Captured with the Phoenix ICON (100° field of view) · infant wide-field fundus photograph · 1240x1240px.
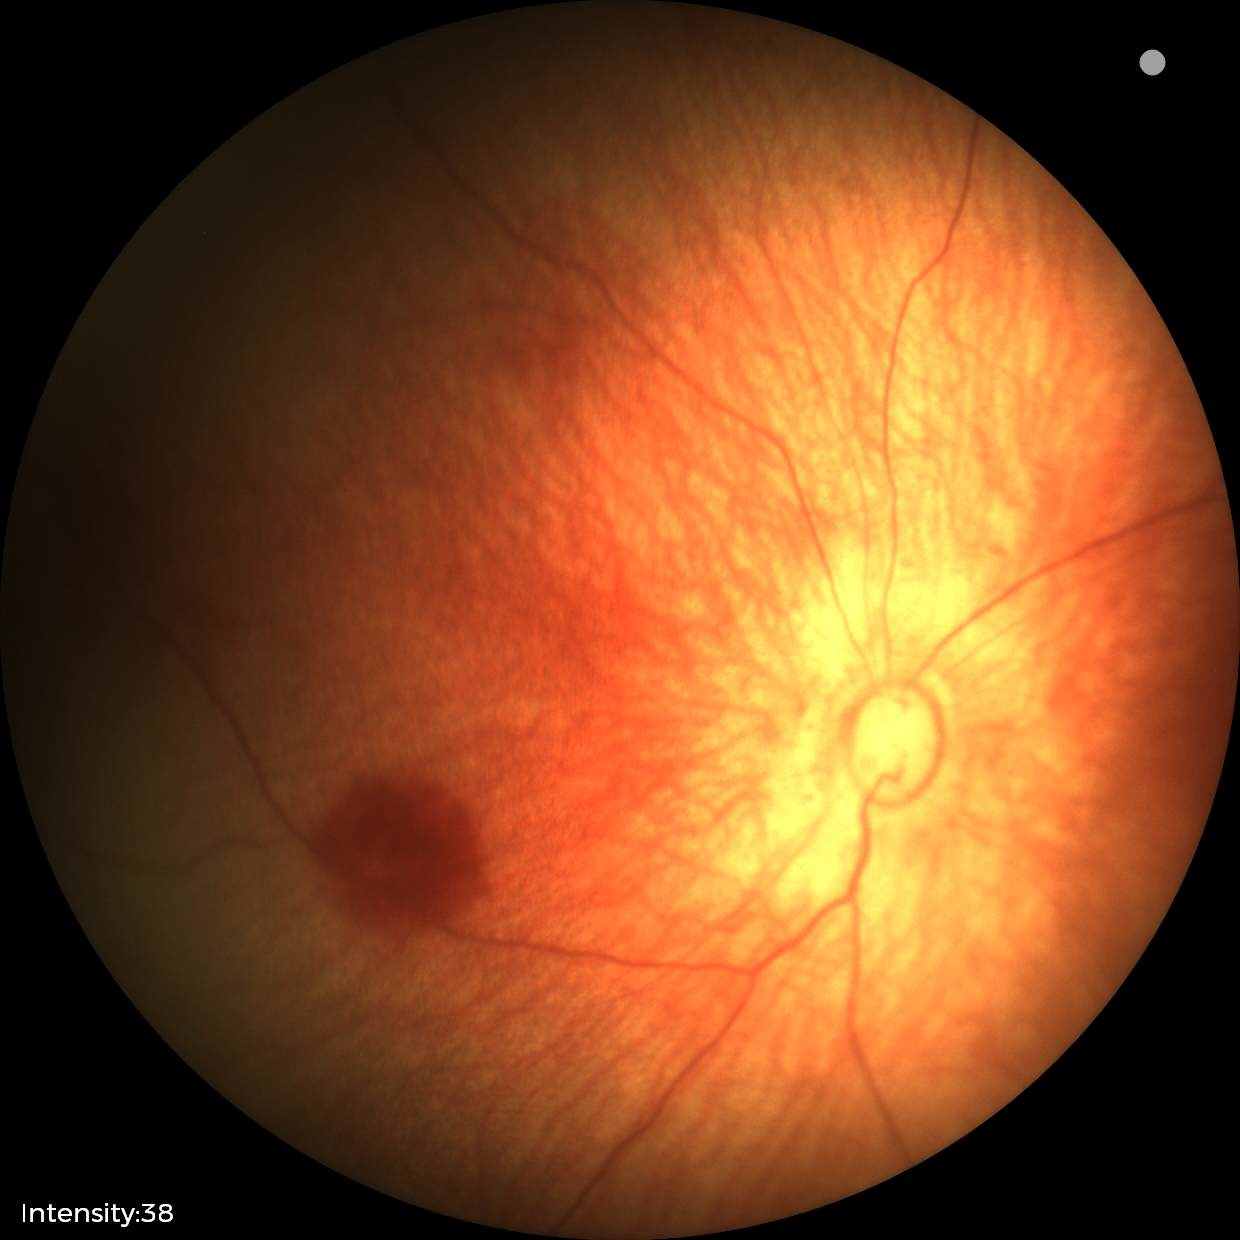
Assessment: normal.